FOV: 45 degrees — 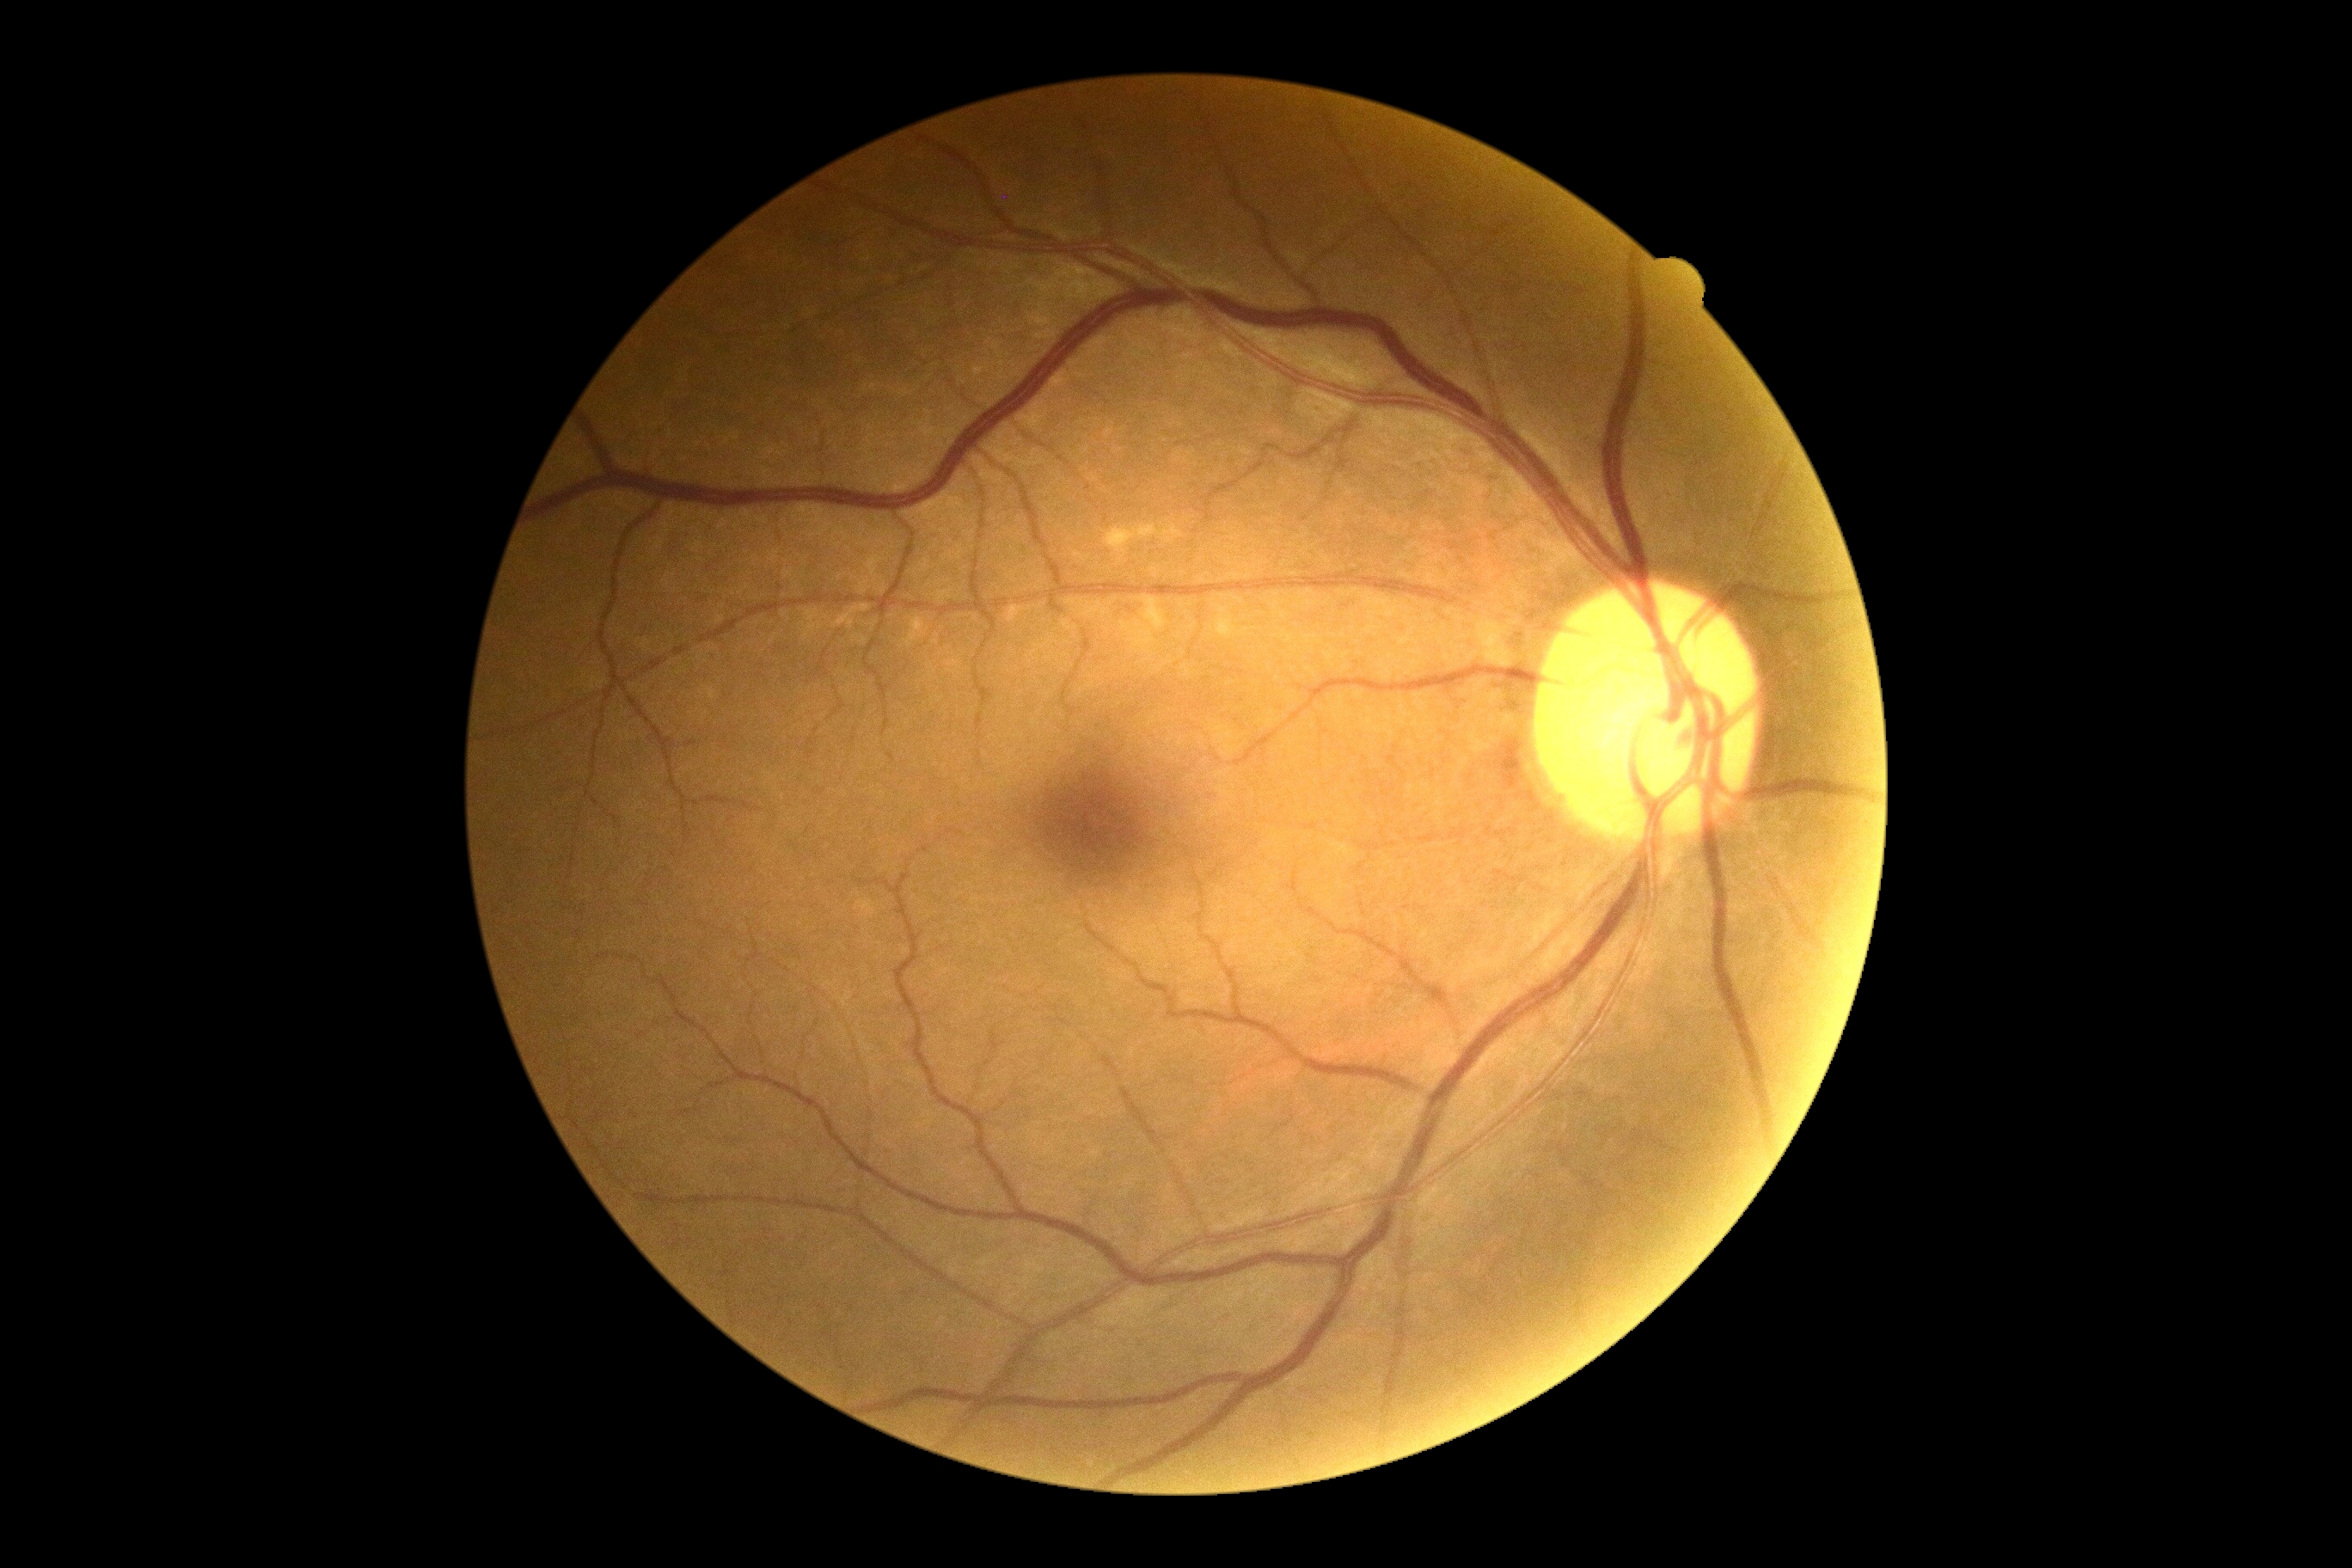
dr_grade: no apparent diabetic retinopathy (0) — no visible signs of diabetic retinopathy